NIDEK AFC-230 fundus camera; 848 by 848 pixels; 45 degree fundus photograph:
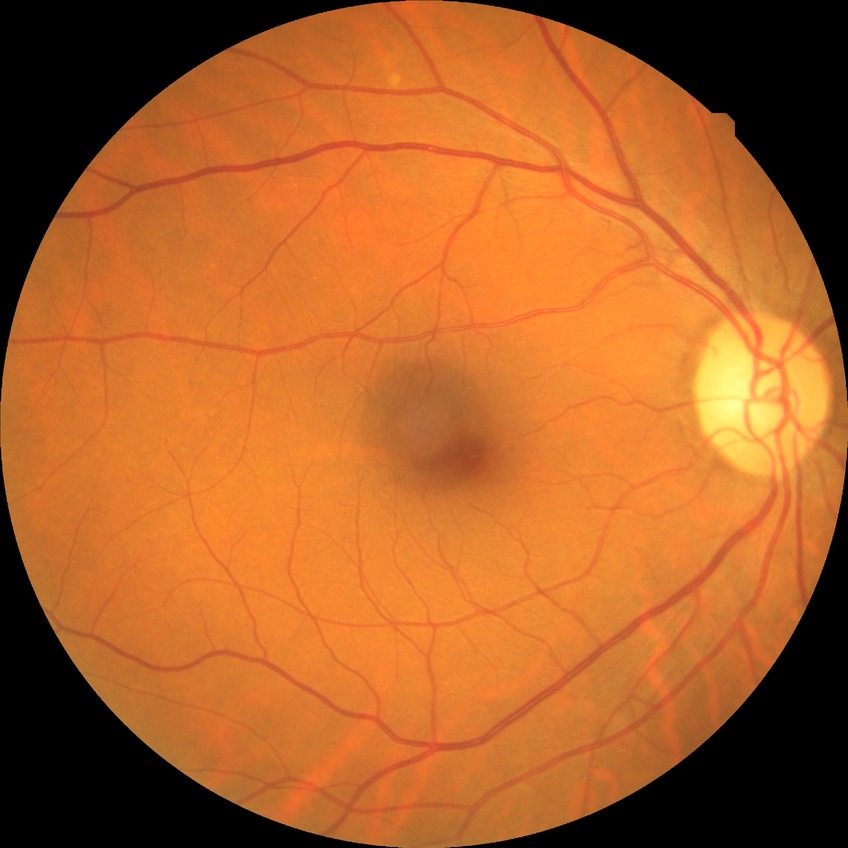 Diabetic retinopathy (DR) is NDR (no diabetic retinopathy).